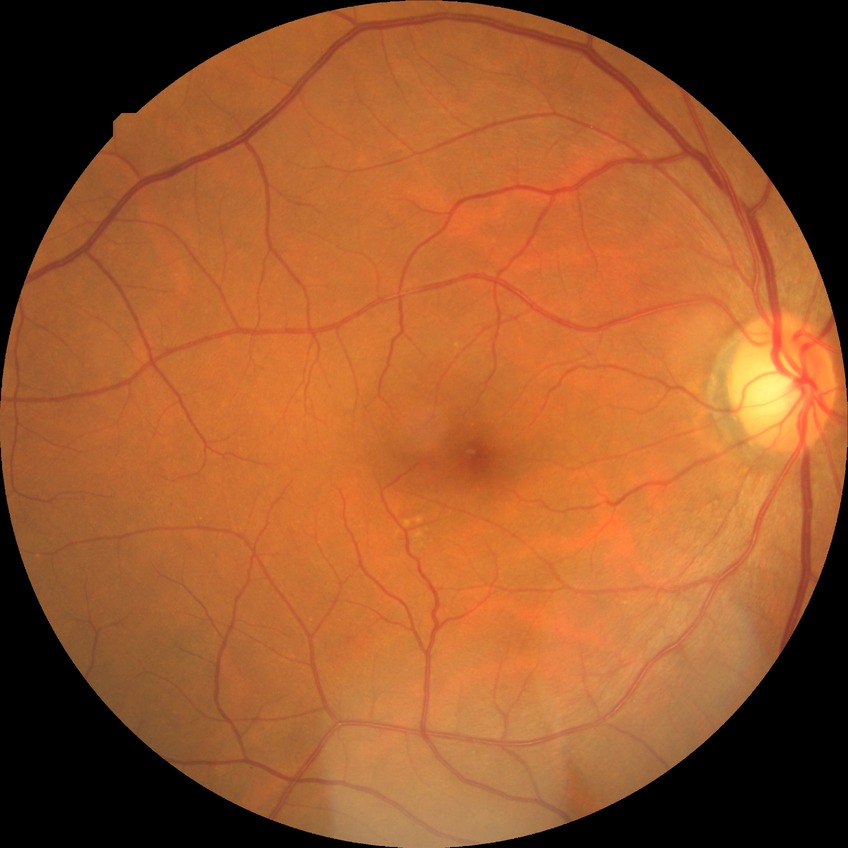

Diabetic retinopathy (DR): NDR (no diabetic retinopathy).